Image size 1932x1932 · color fundus photograph — 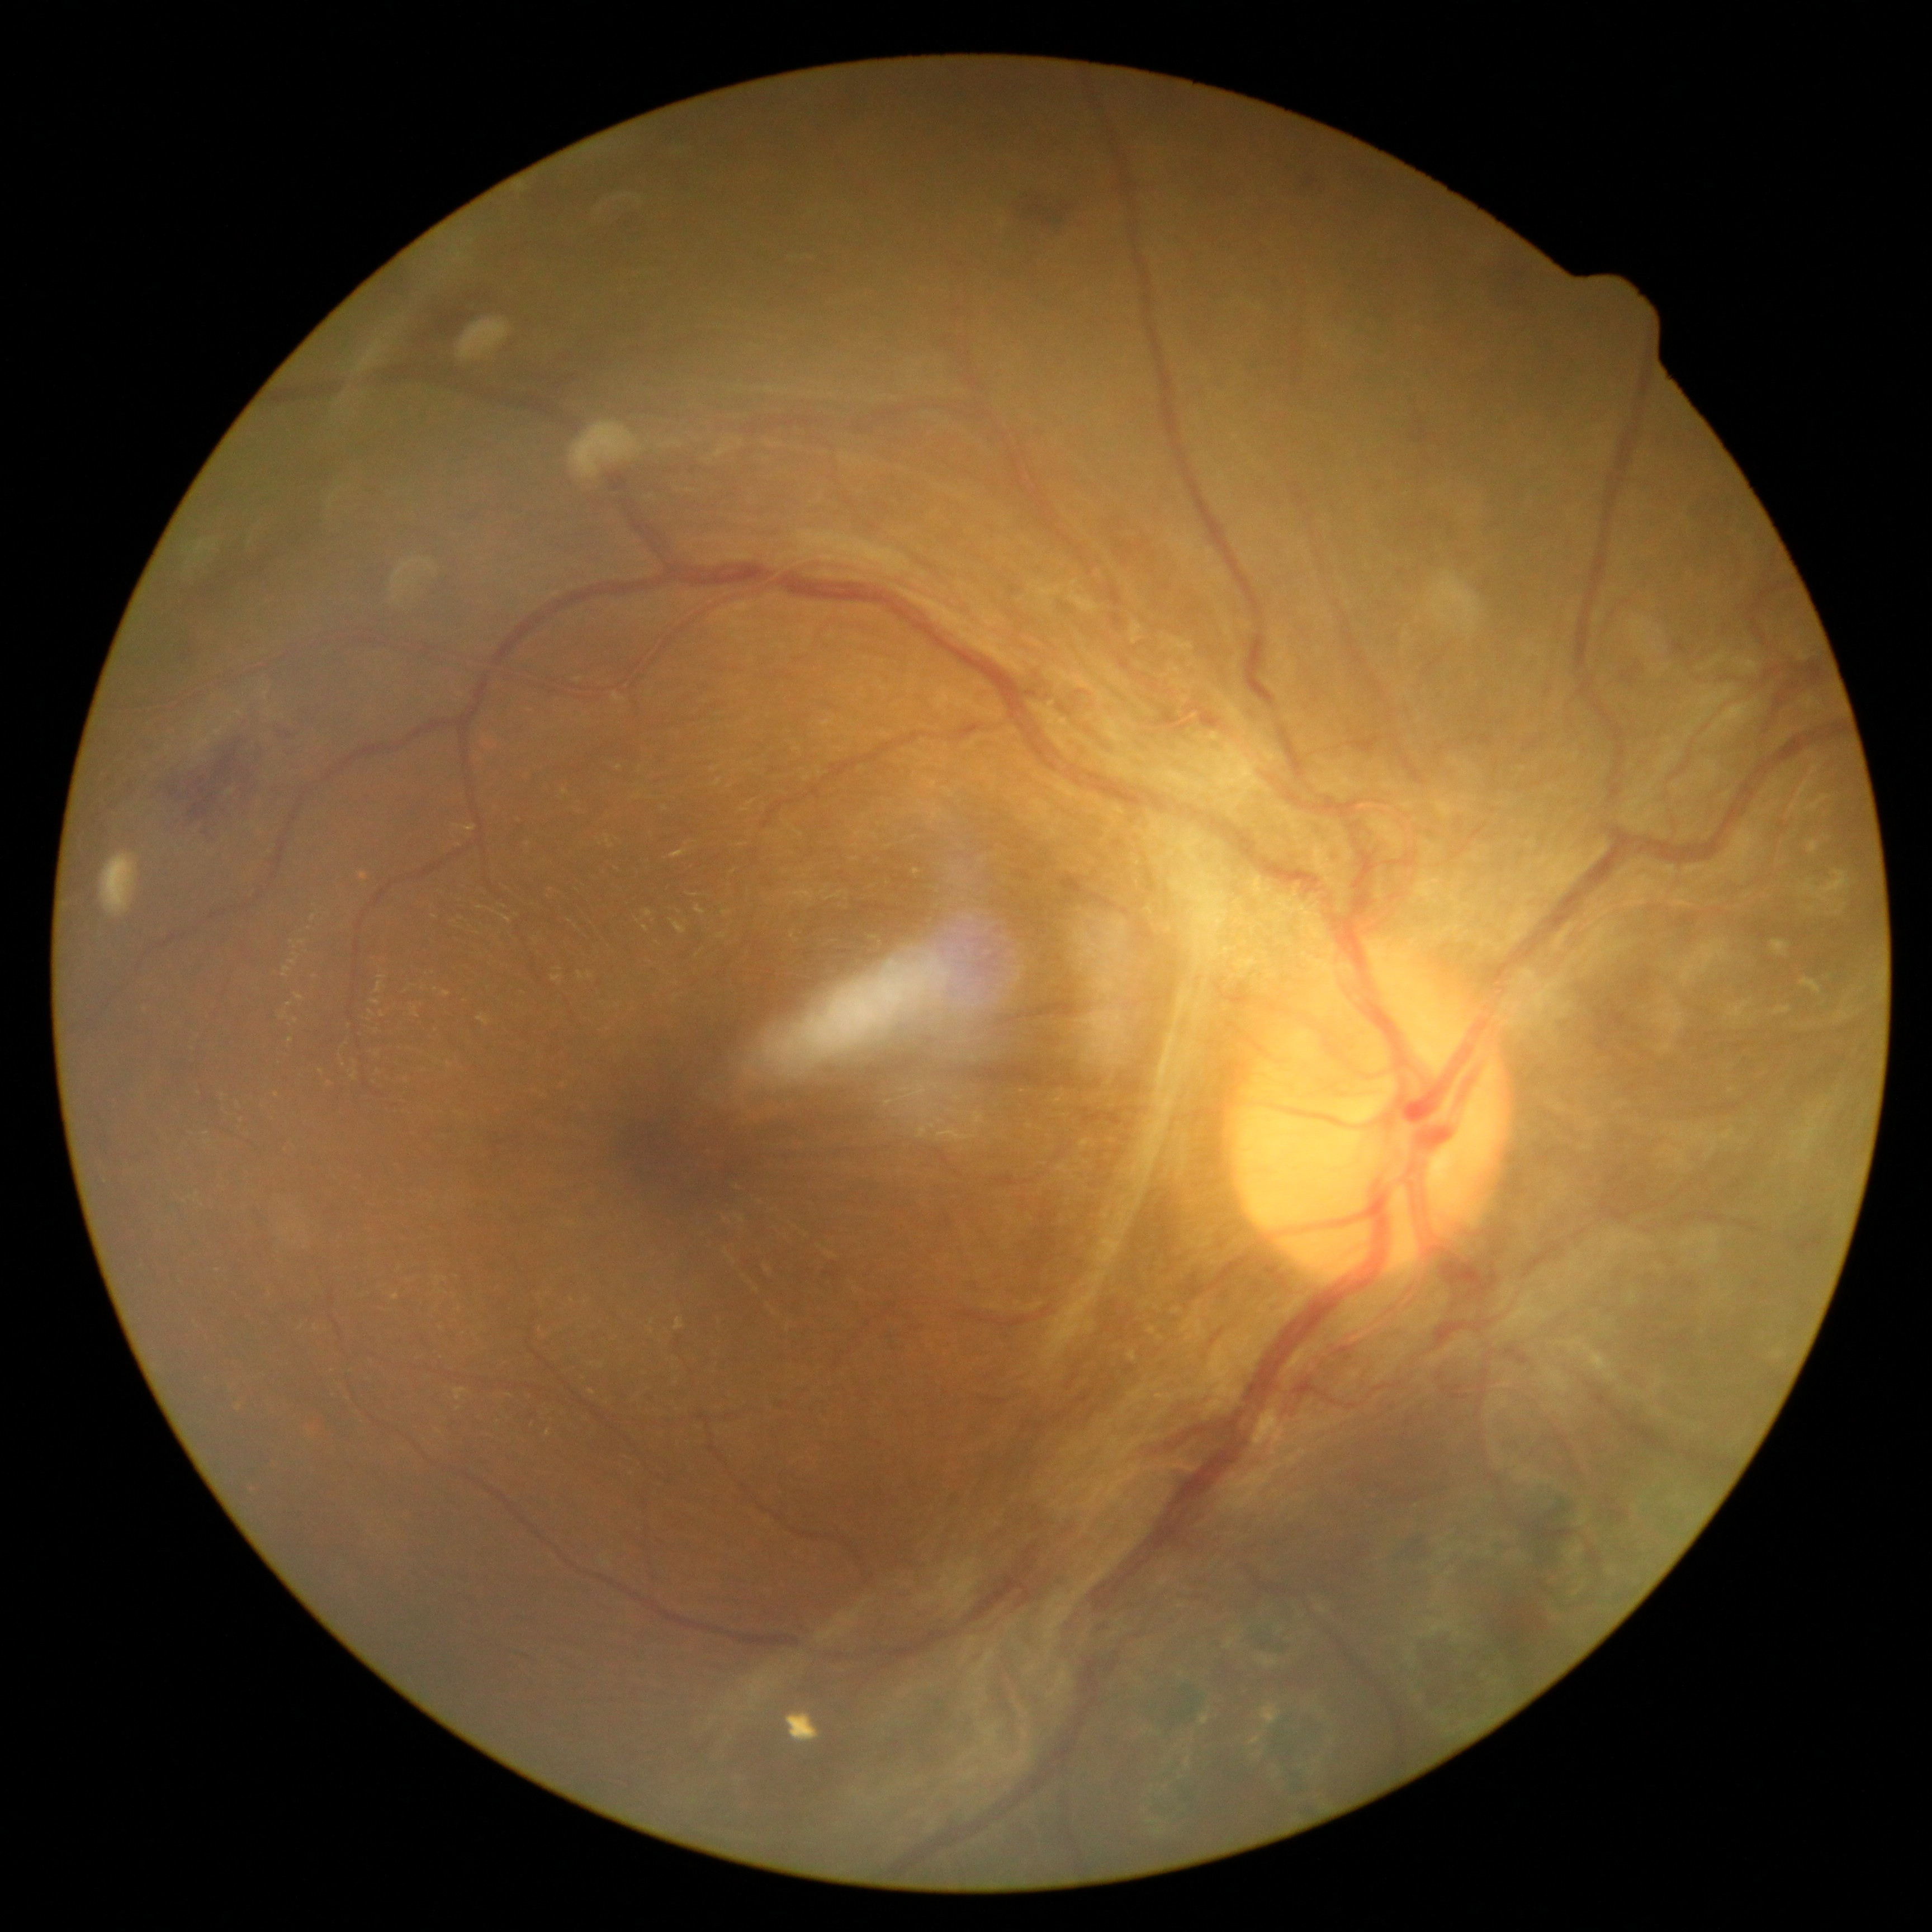
DR stage: proliferative diabetic retinopathy (grade 4).